Wide-field retinal mosaic image
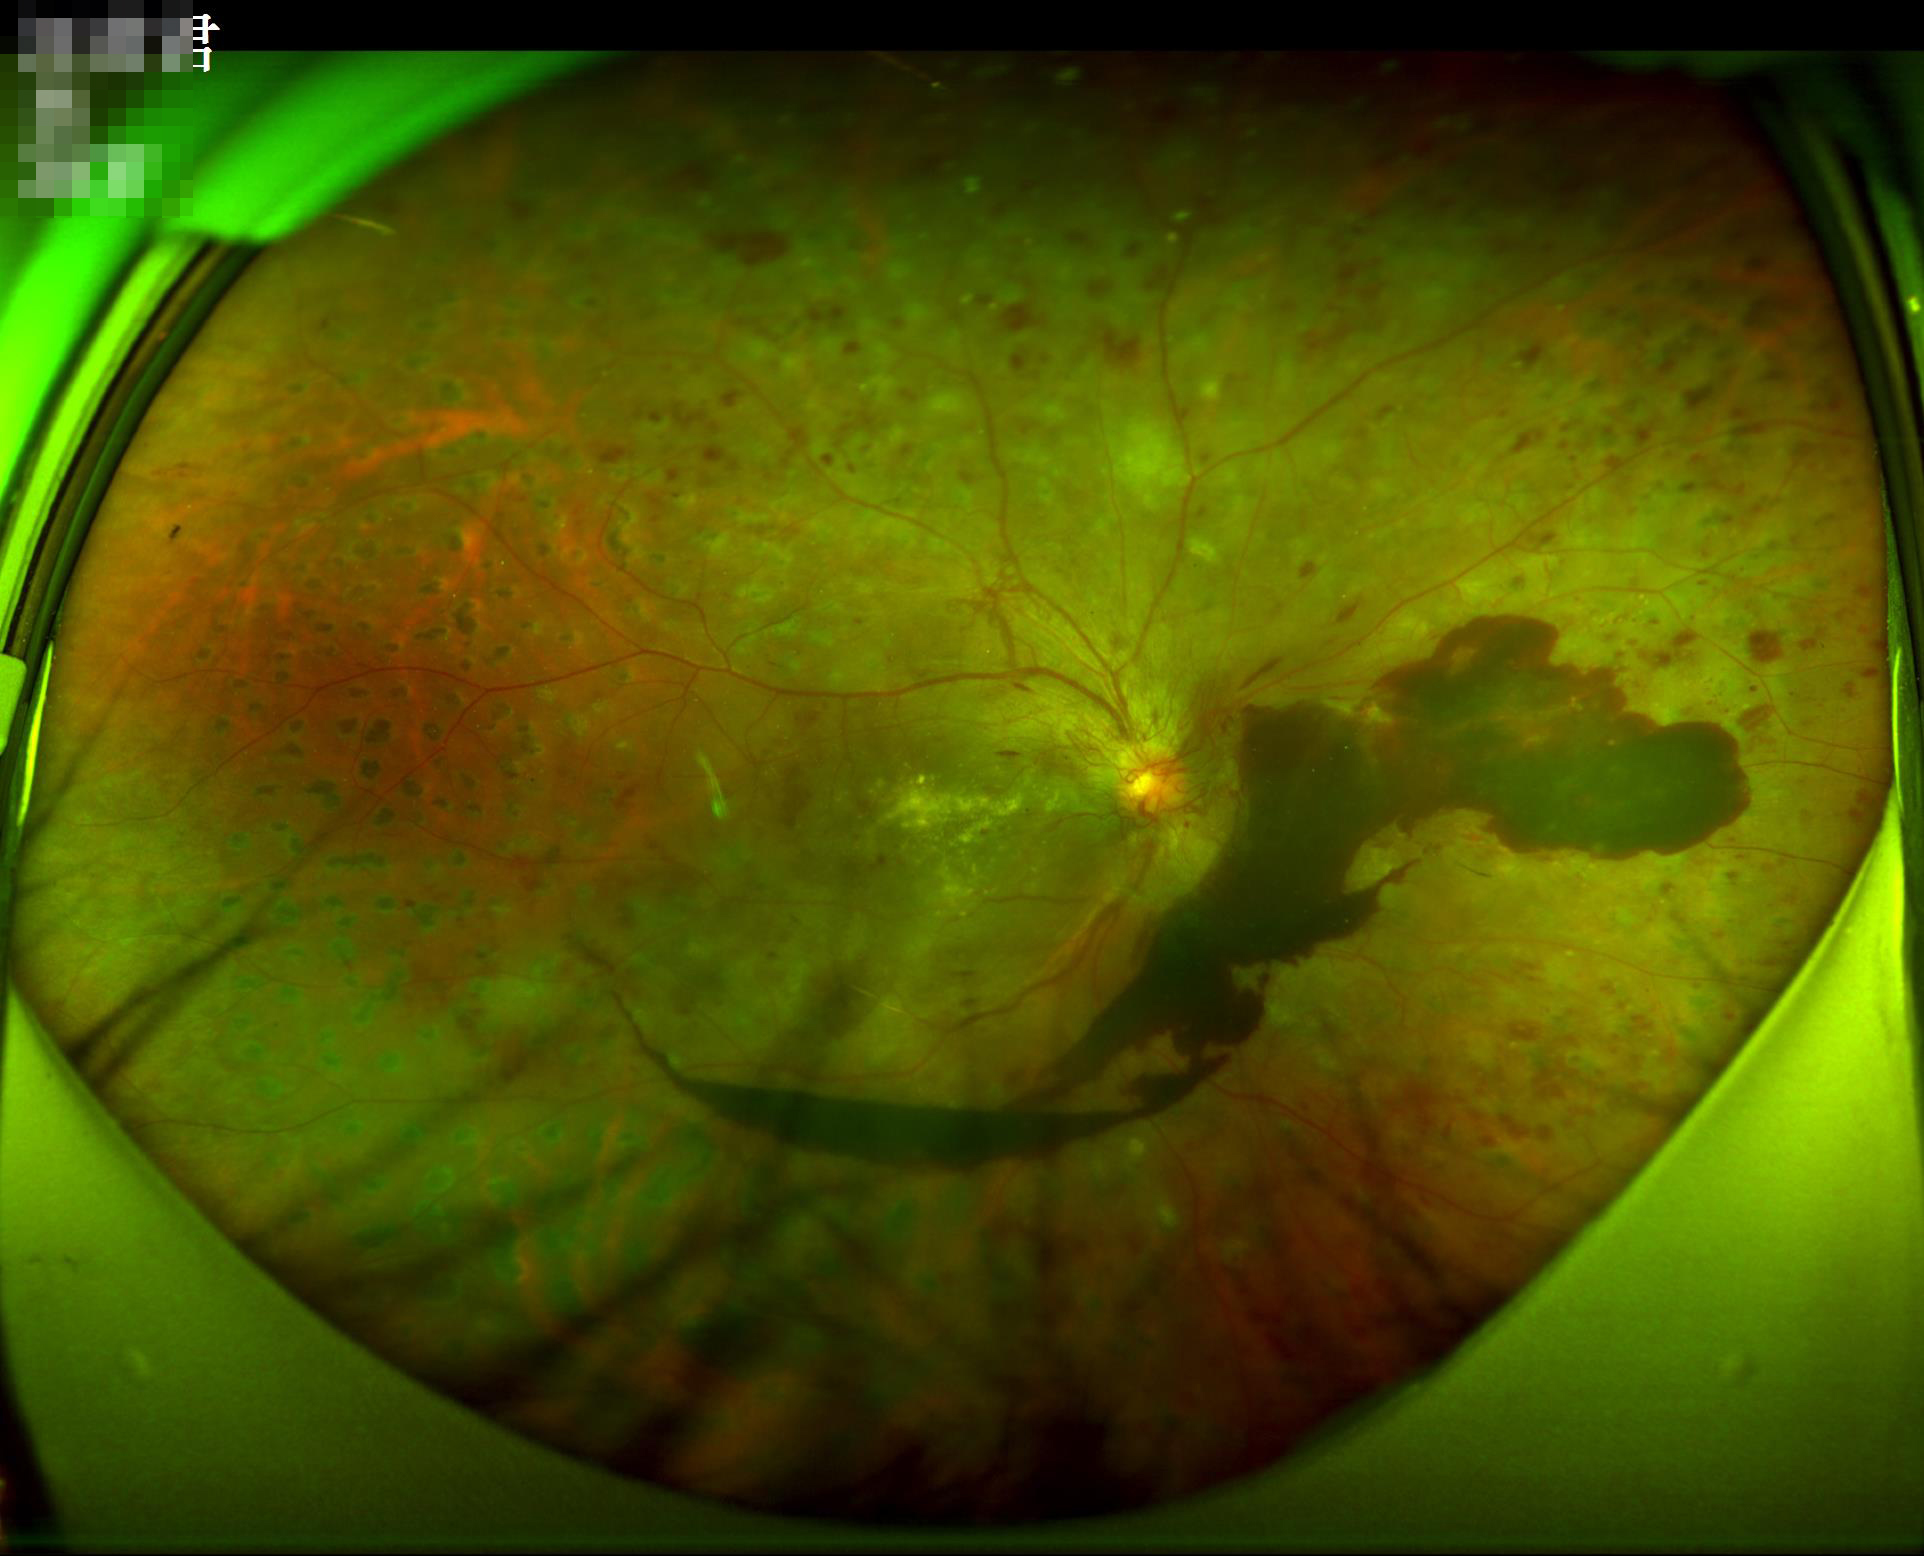 Illumination: even and well-balanced
Clarity: sharp throughout the field
Contrast: vessels and details readily distinguishable
Overall image quality: good and suitable for diagnostic use